Infant wide-field fundus photograph · Clarity RetCam 3, 130° FOV
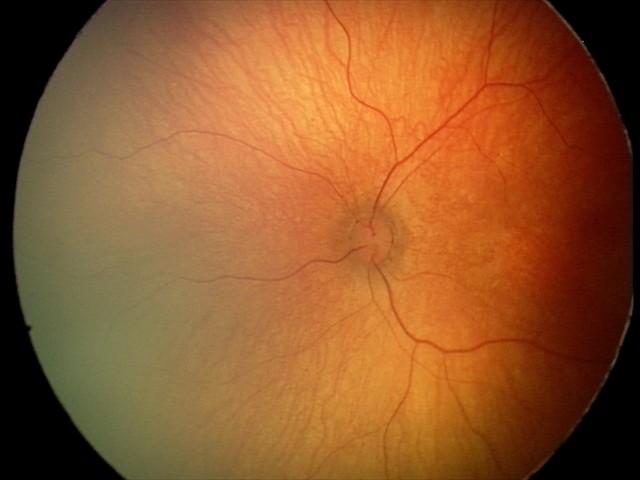 Screening examination with no abnormal retinal findings.